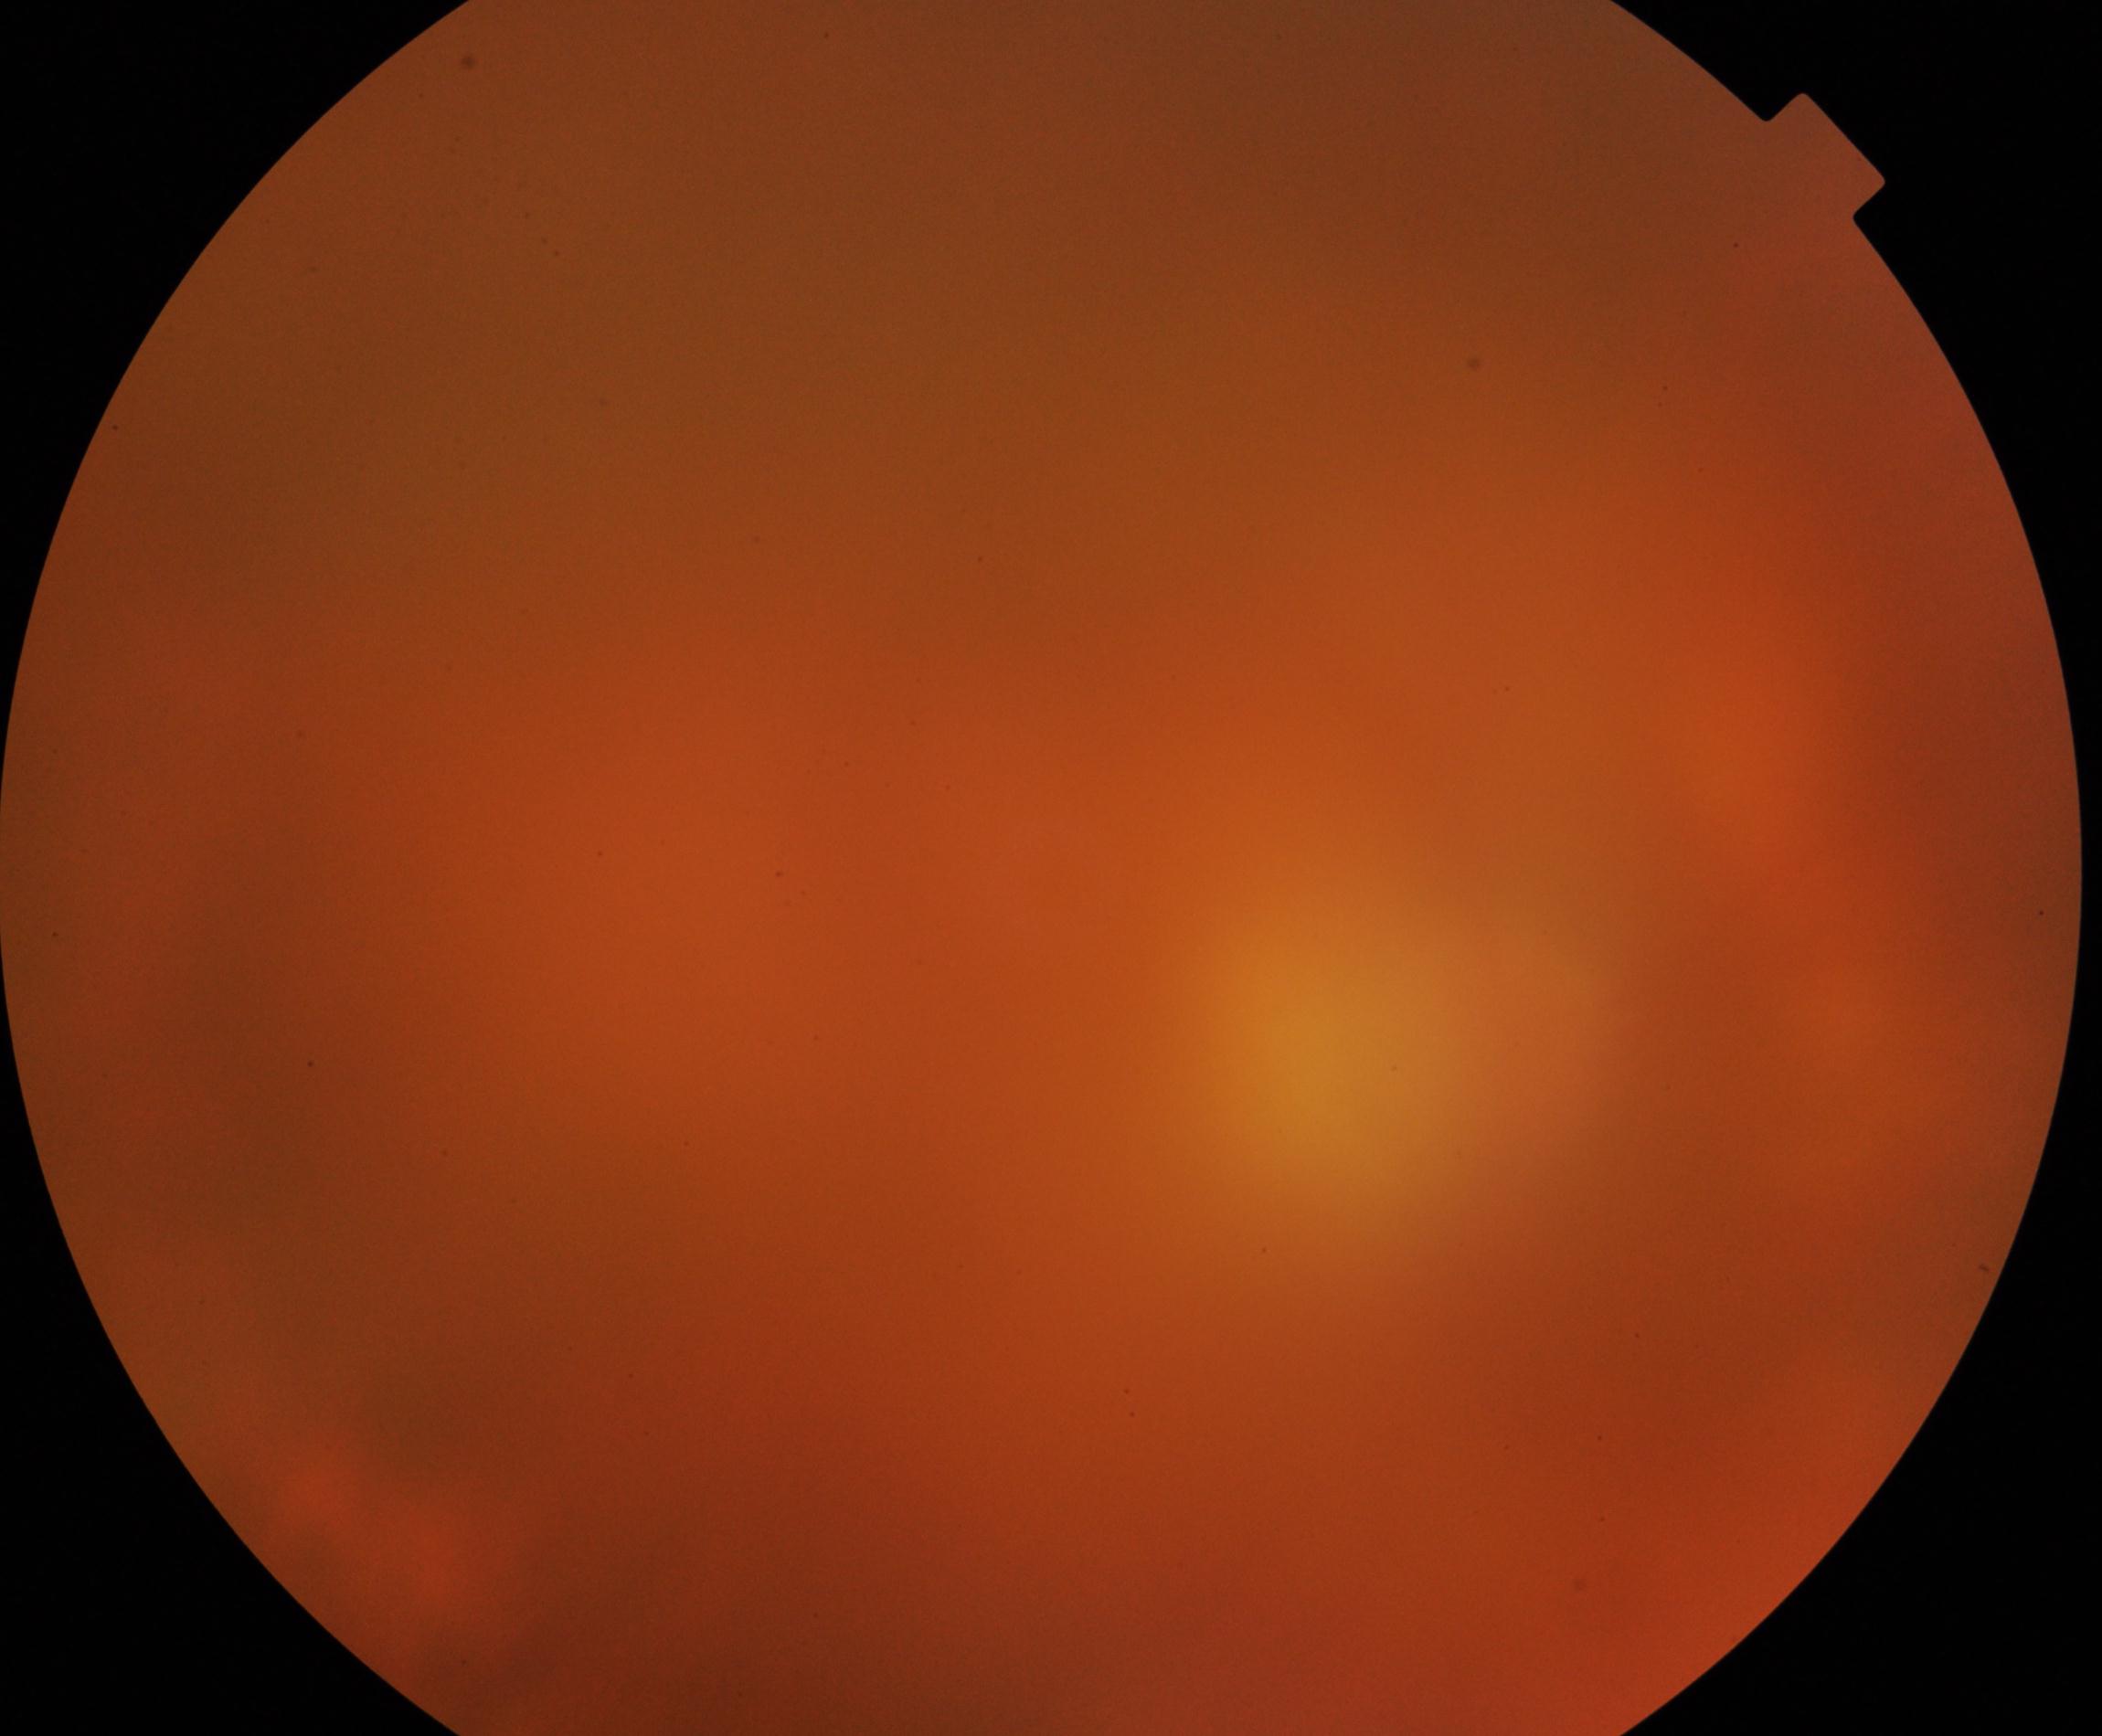 Image quality: poor. Proliferative retinopathy: negative.